45 degree fundus photograph. Posterior pole color fundus photograph. Image size 848x848: 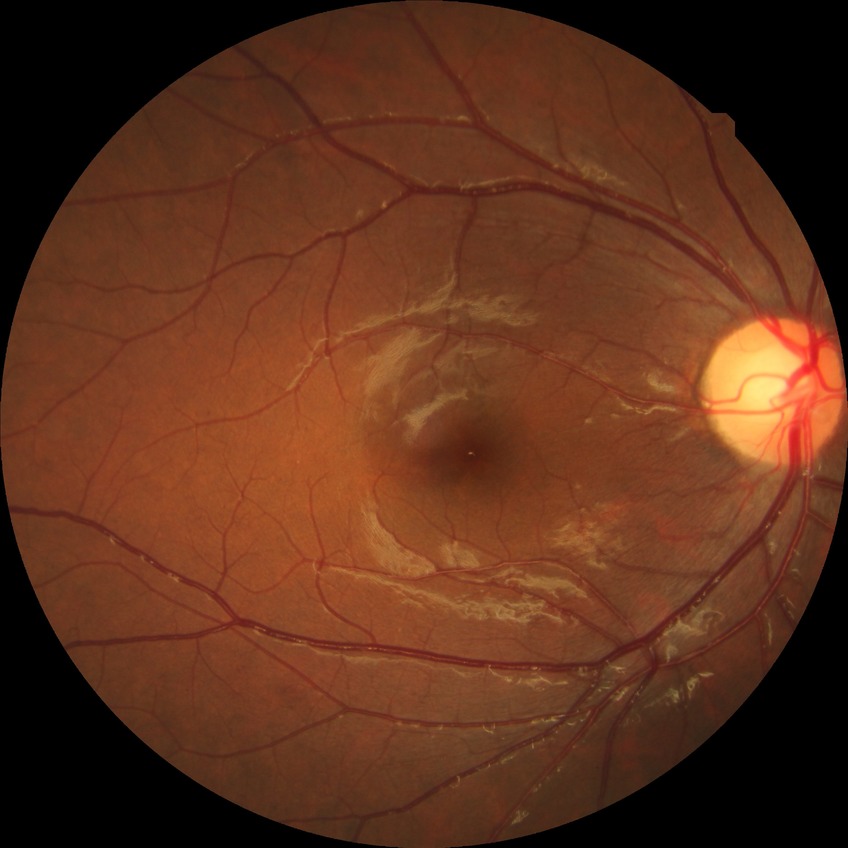

DR class = non-proliferative diabetic retinopathy; Davis stage = SDR.